1659x2212px: 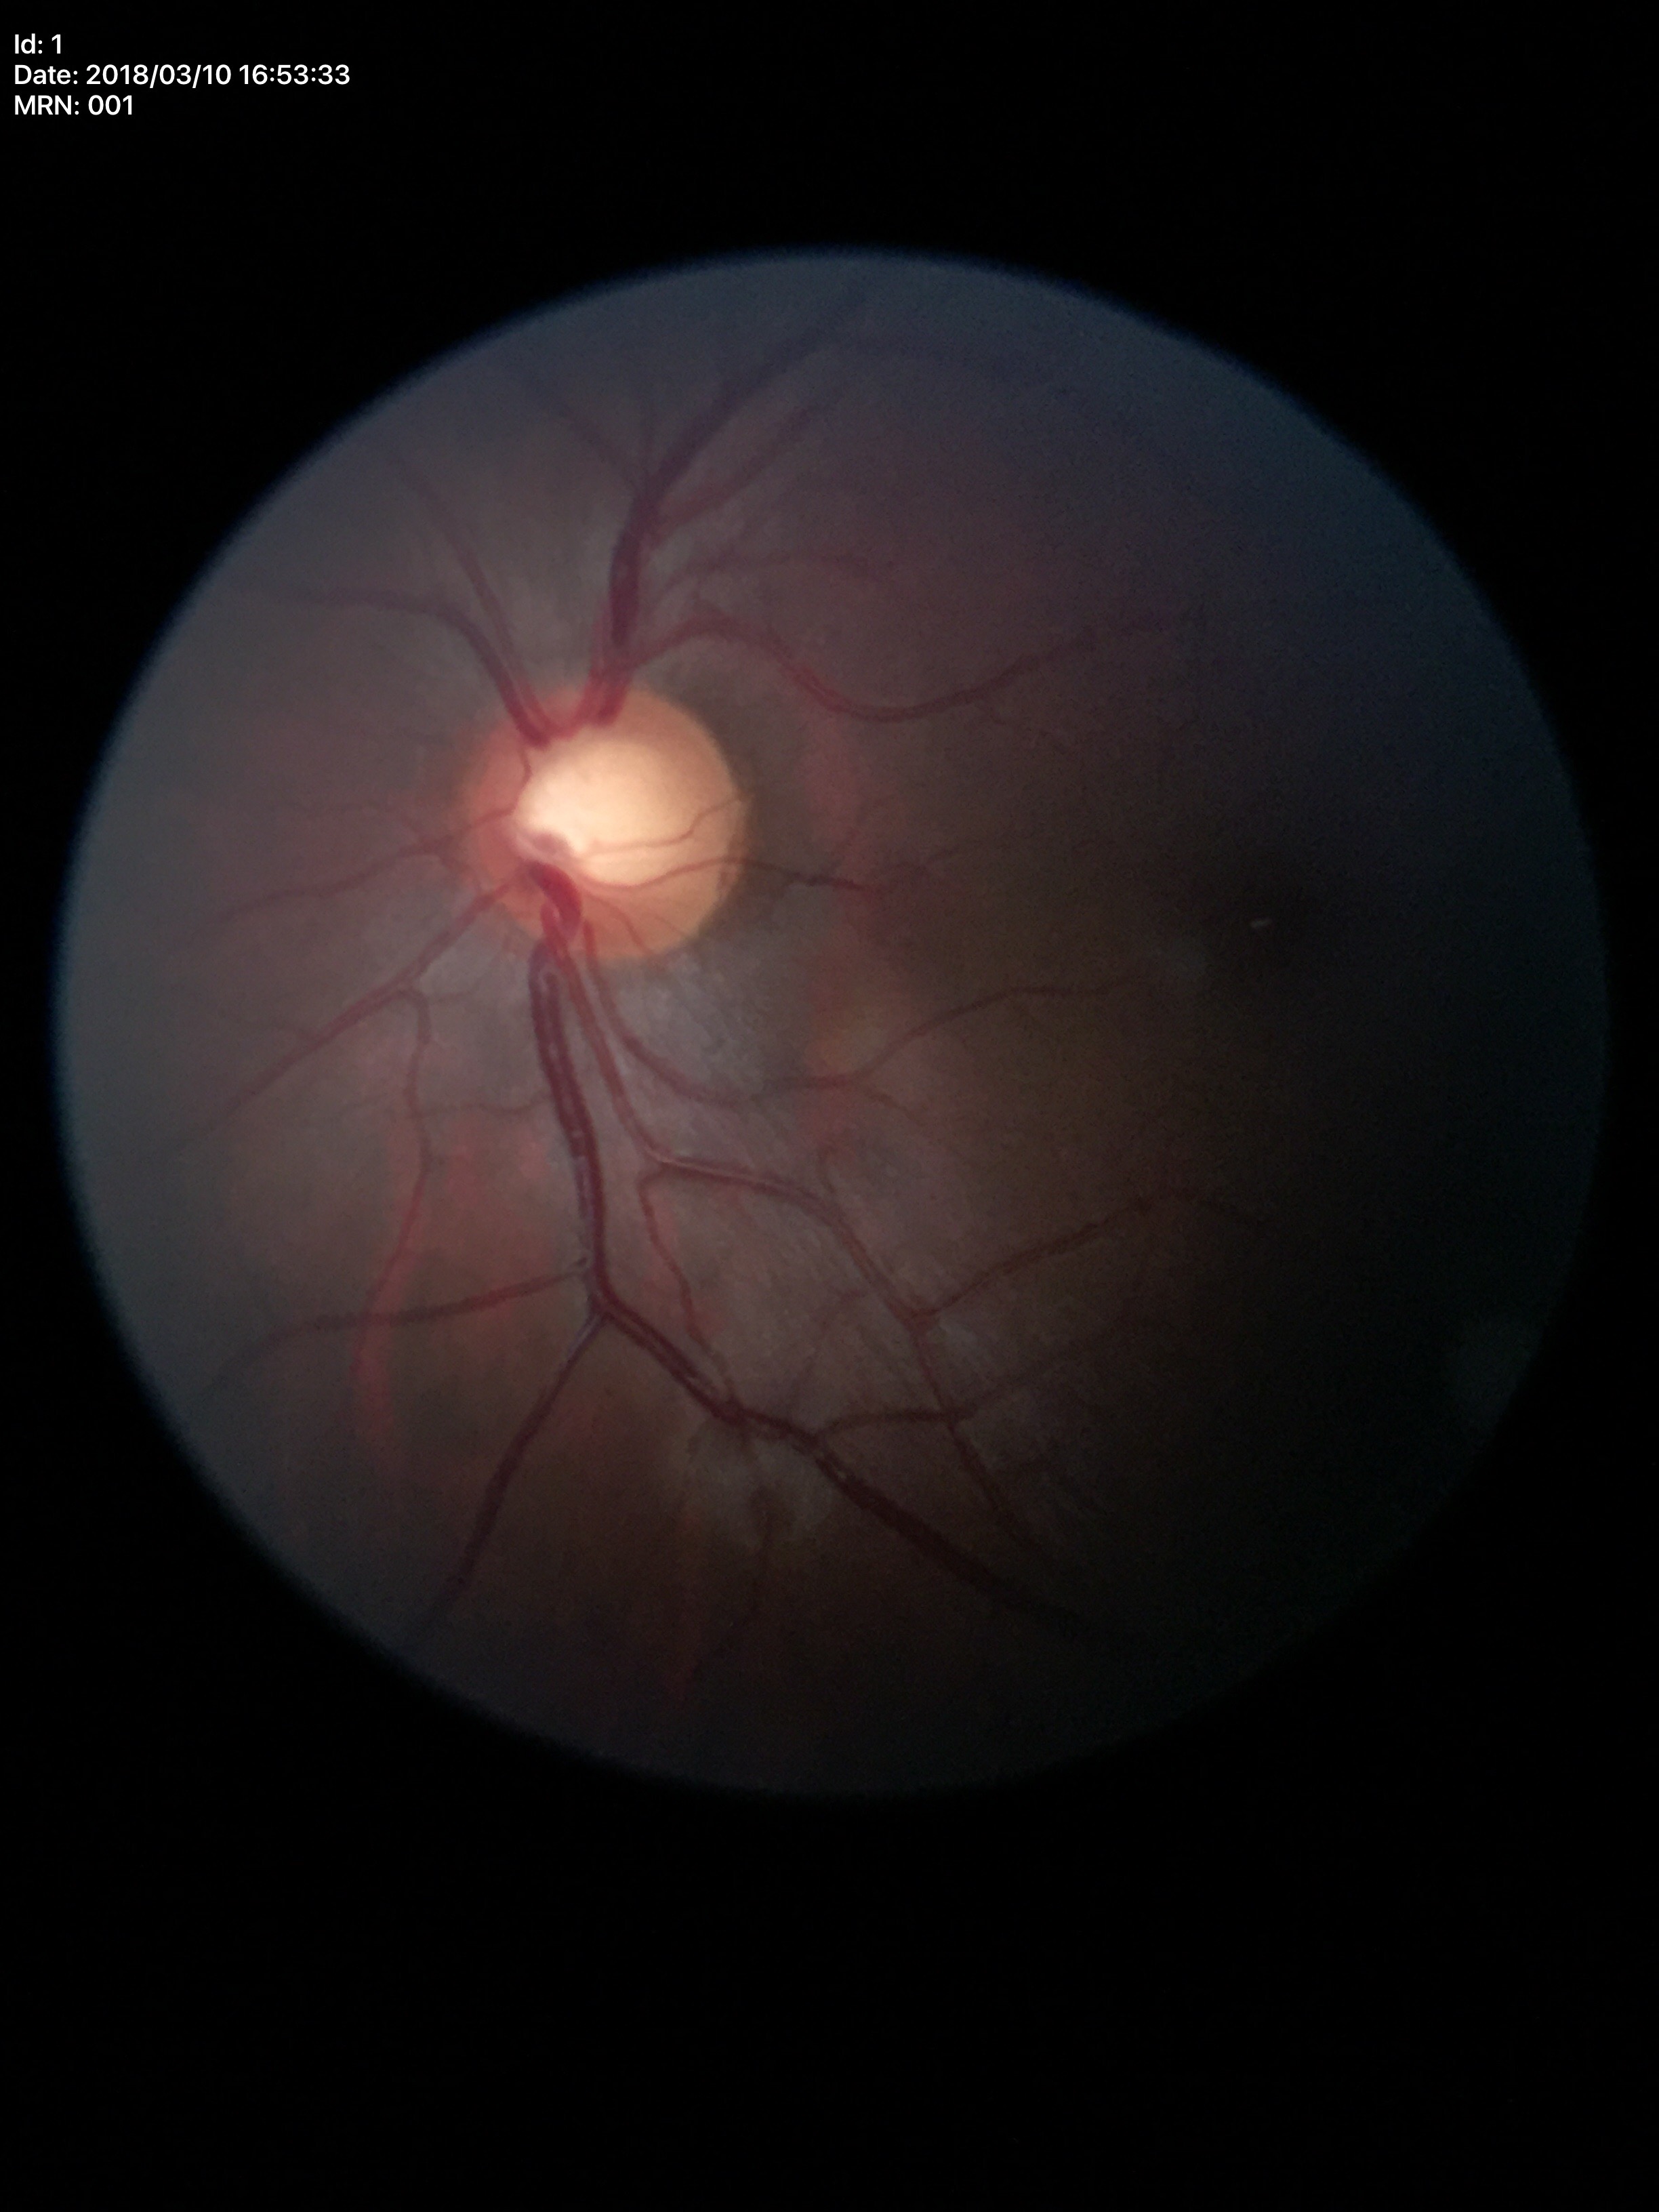 Glaucoma assessment=suspect
VCDR=0.63